FOV: 45 degrees. 848 by 848 pixels — 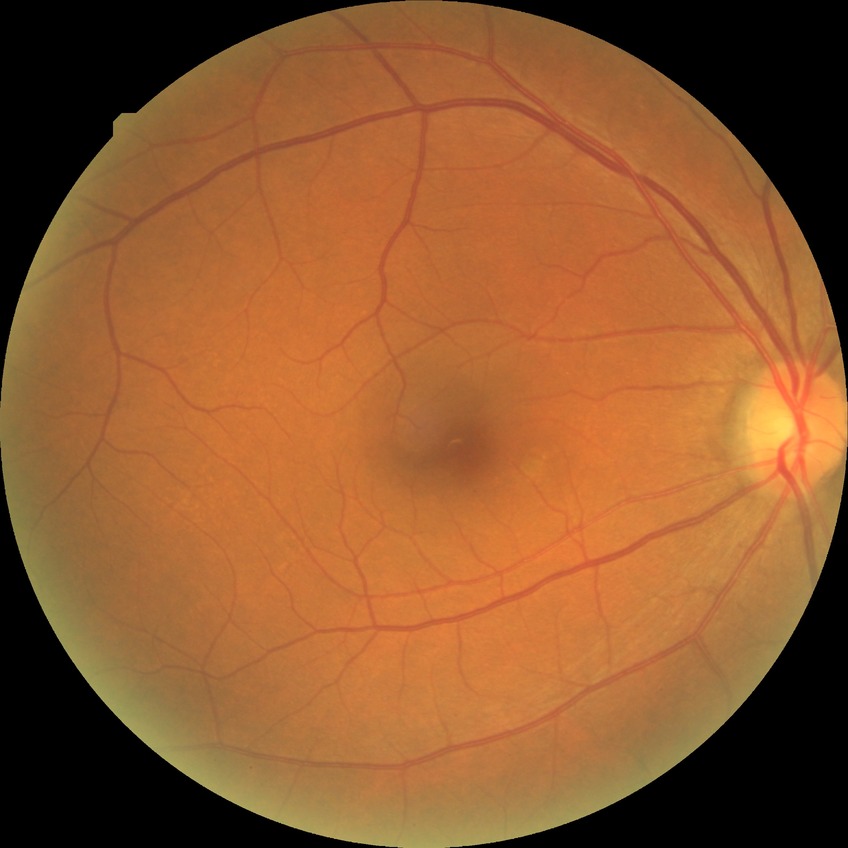
diabetic retinopathy severity: no diabetic retinopathy.